Image size 2352x1568; FOV: 45 degrees: 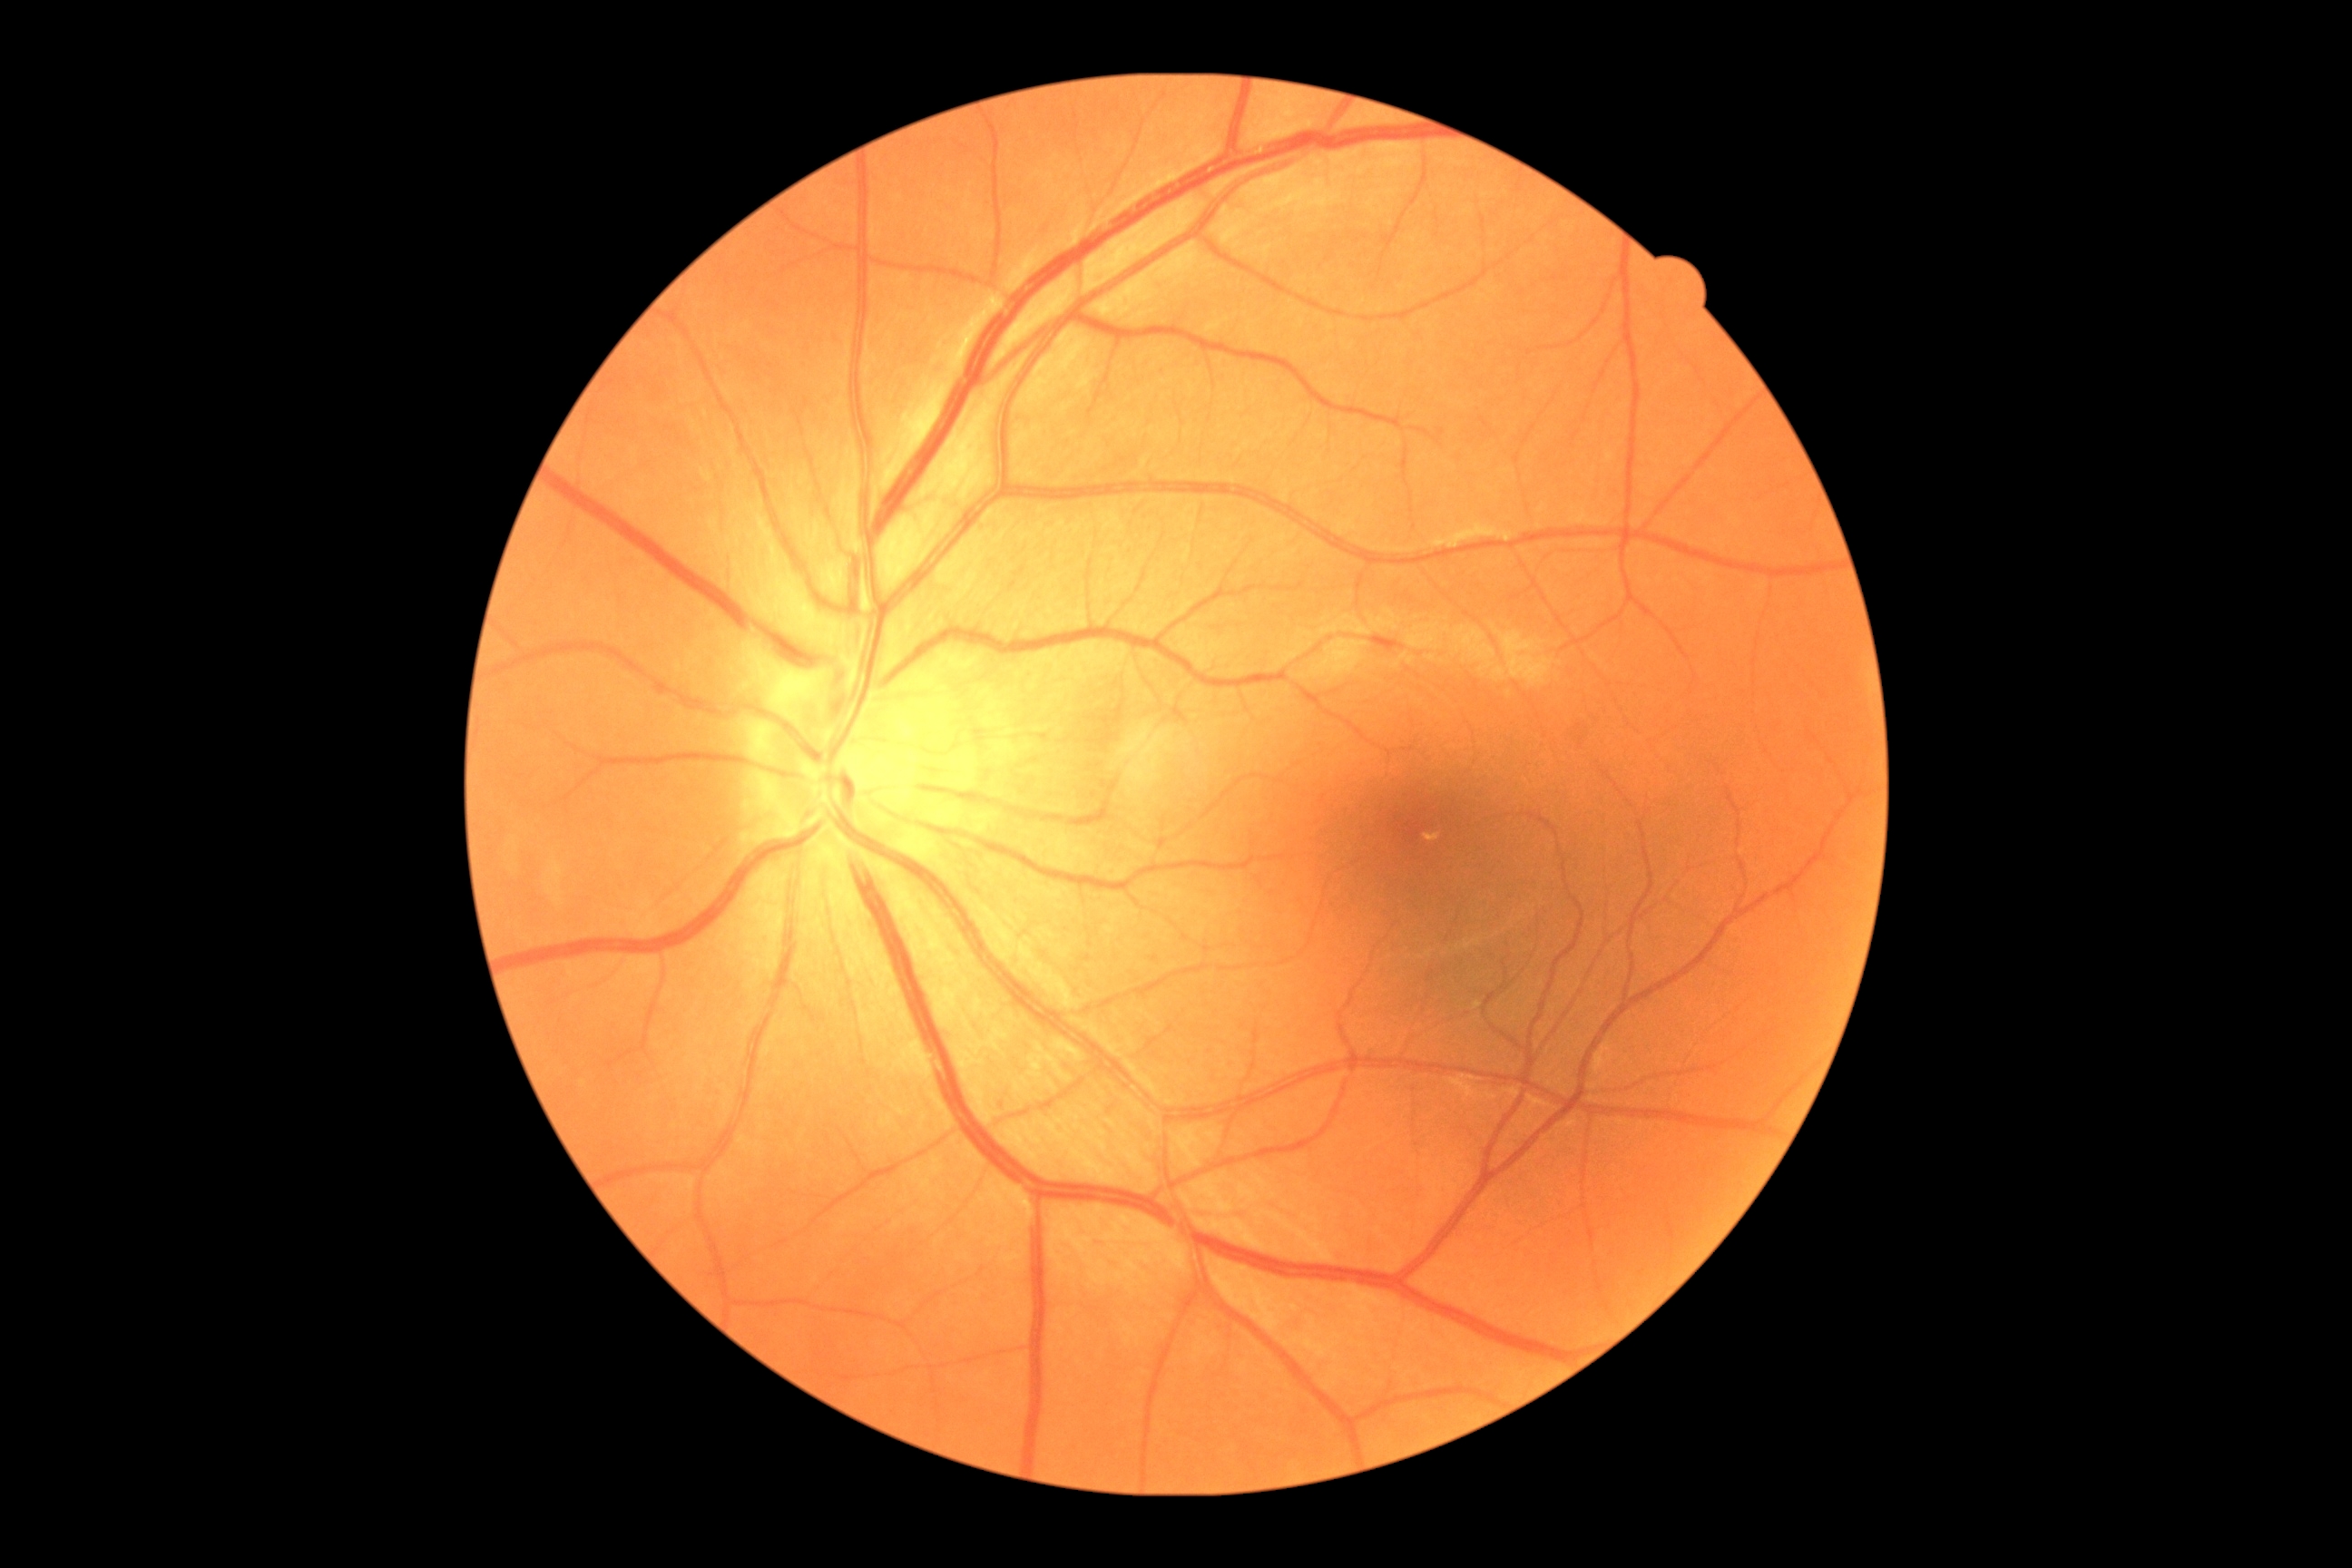 Retinopathy grade: 0 (no apparent retinopathy).